2352 by 1568 pixels — 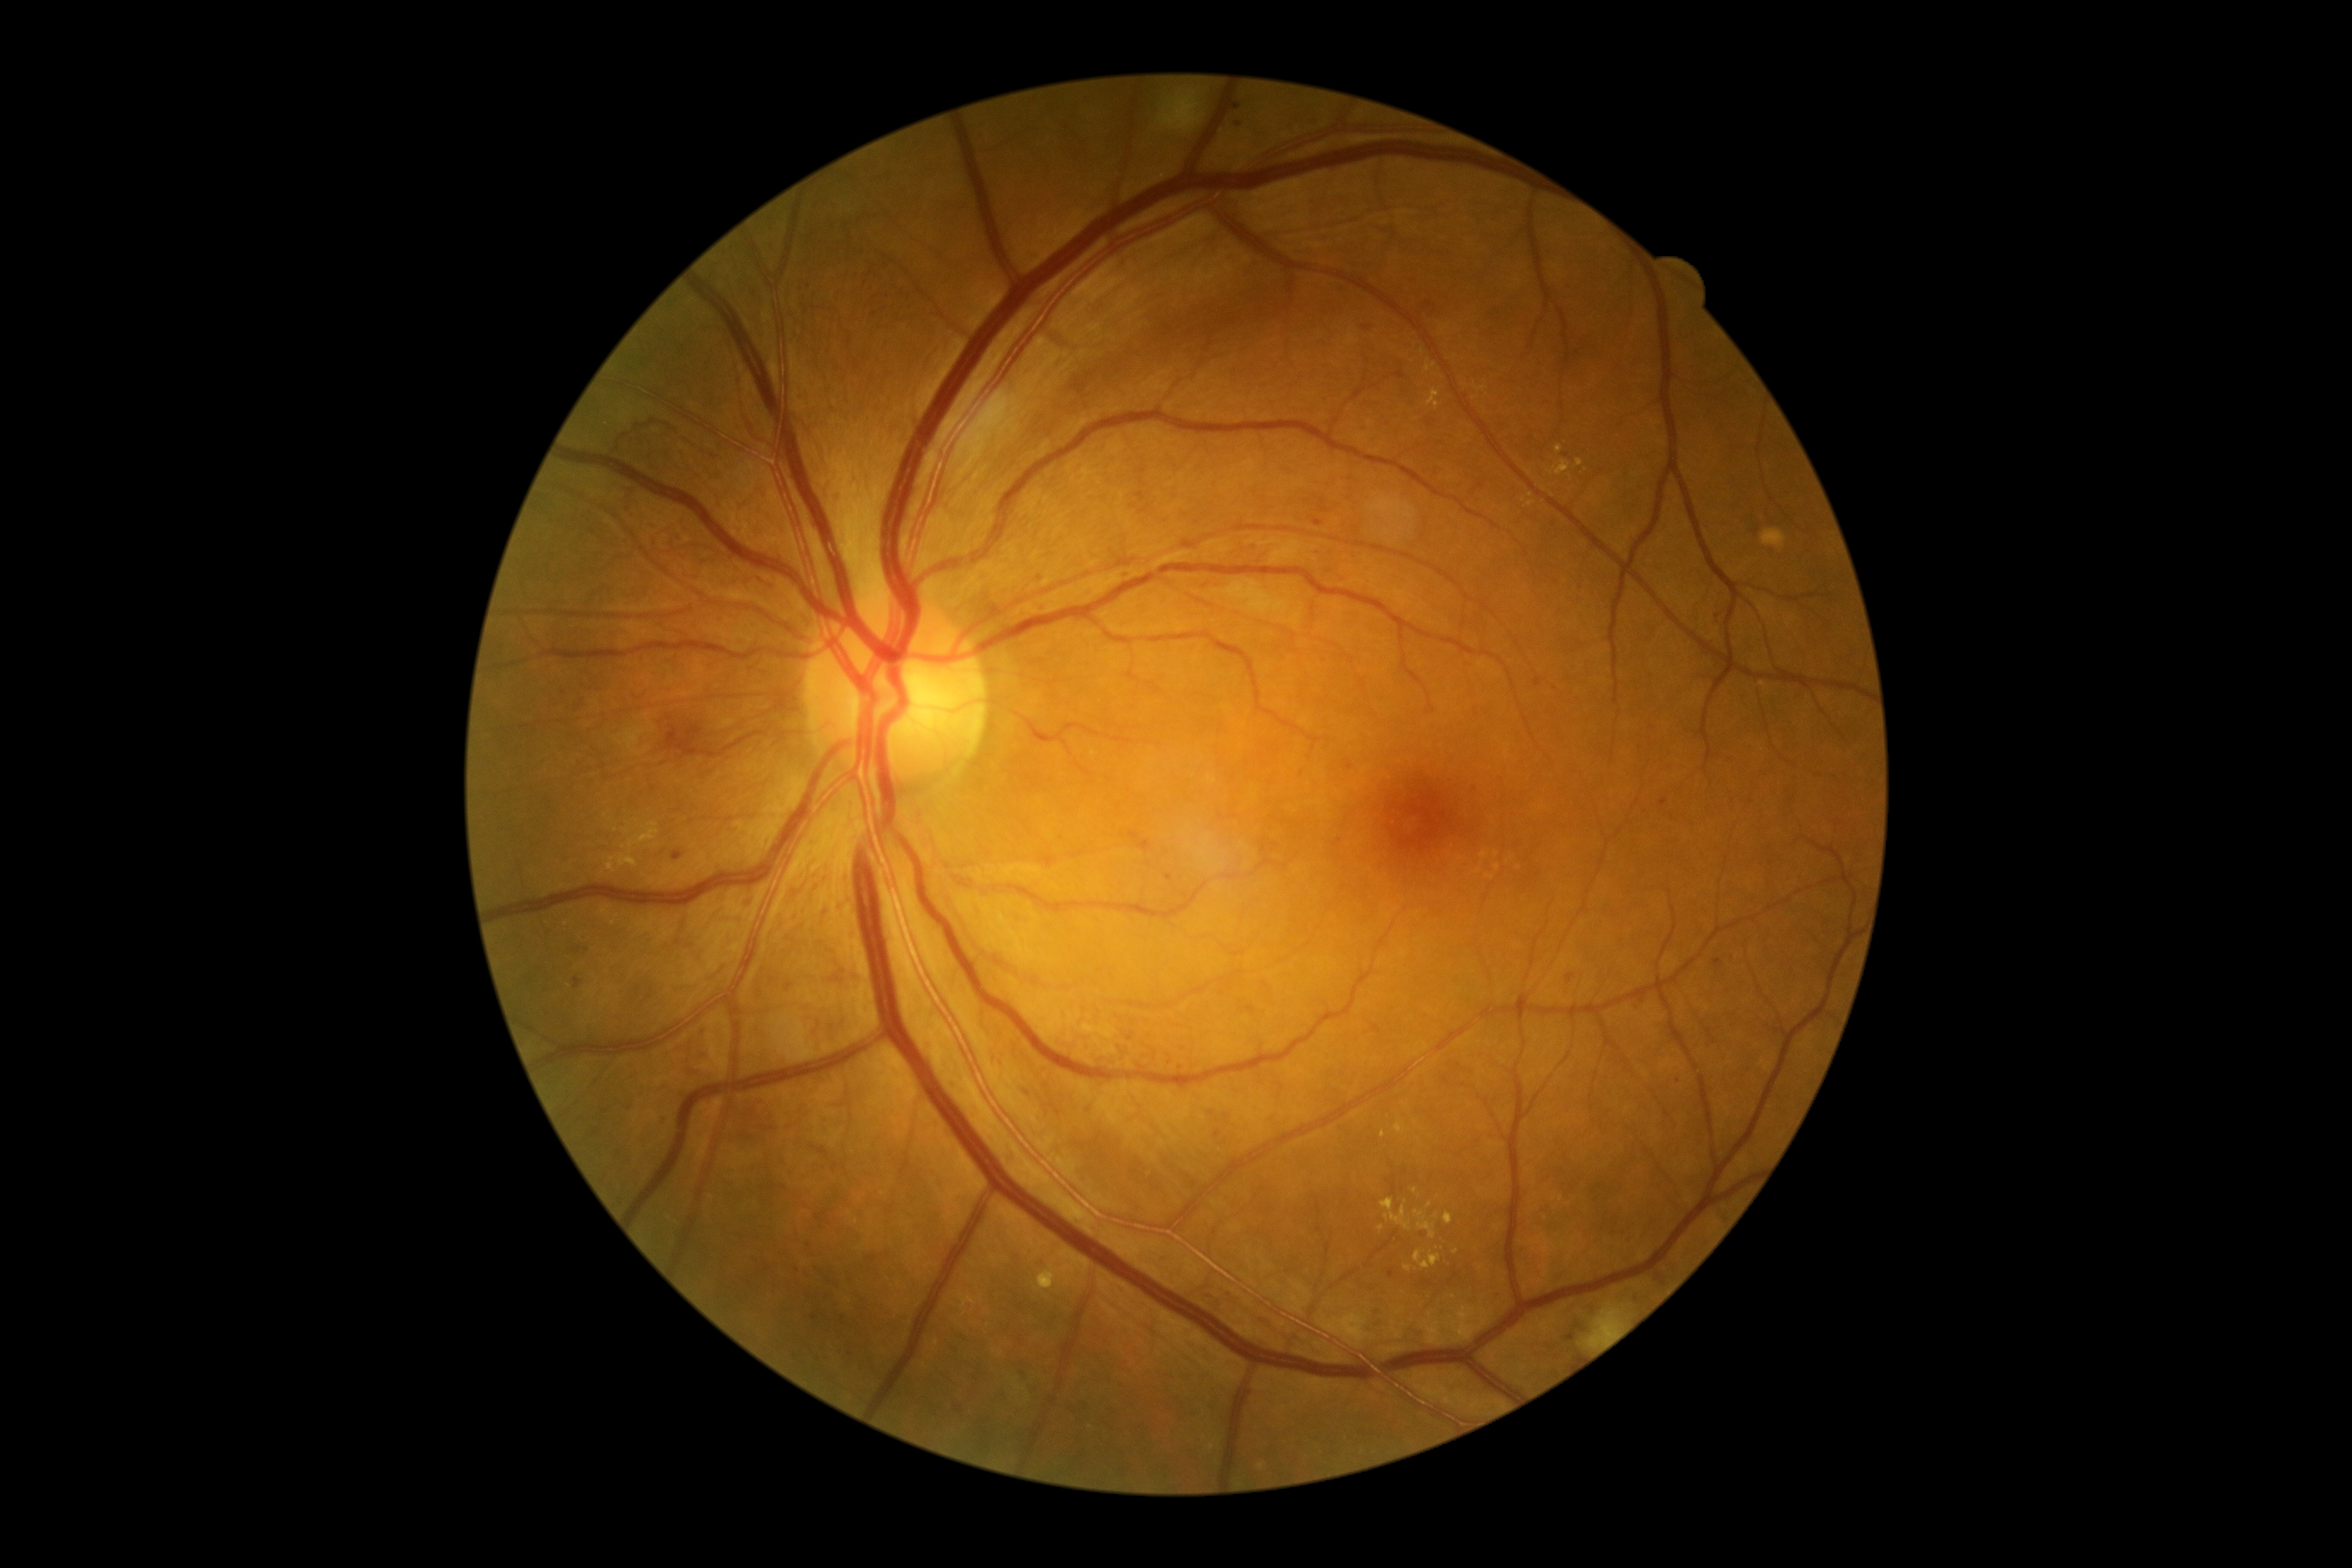 DR stage is grade 3 (severe NPDR).